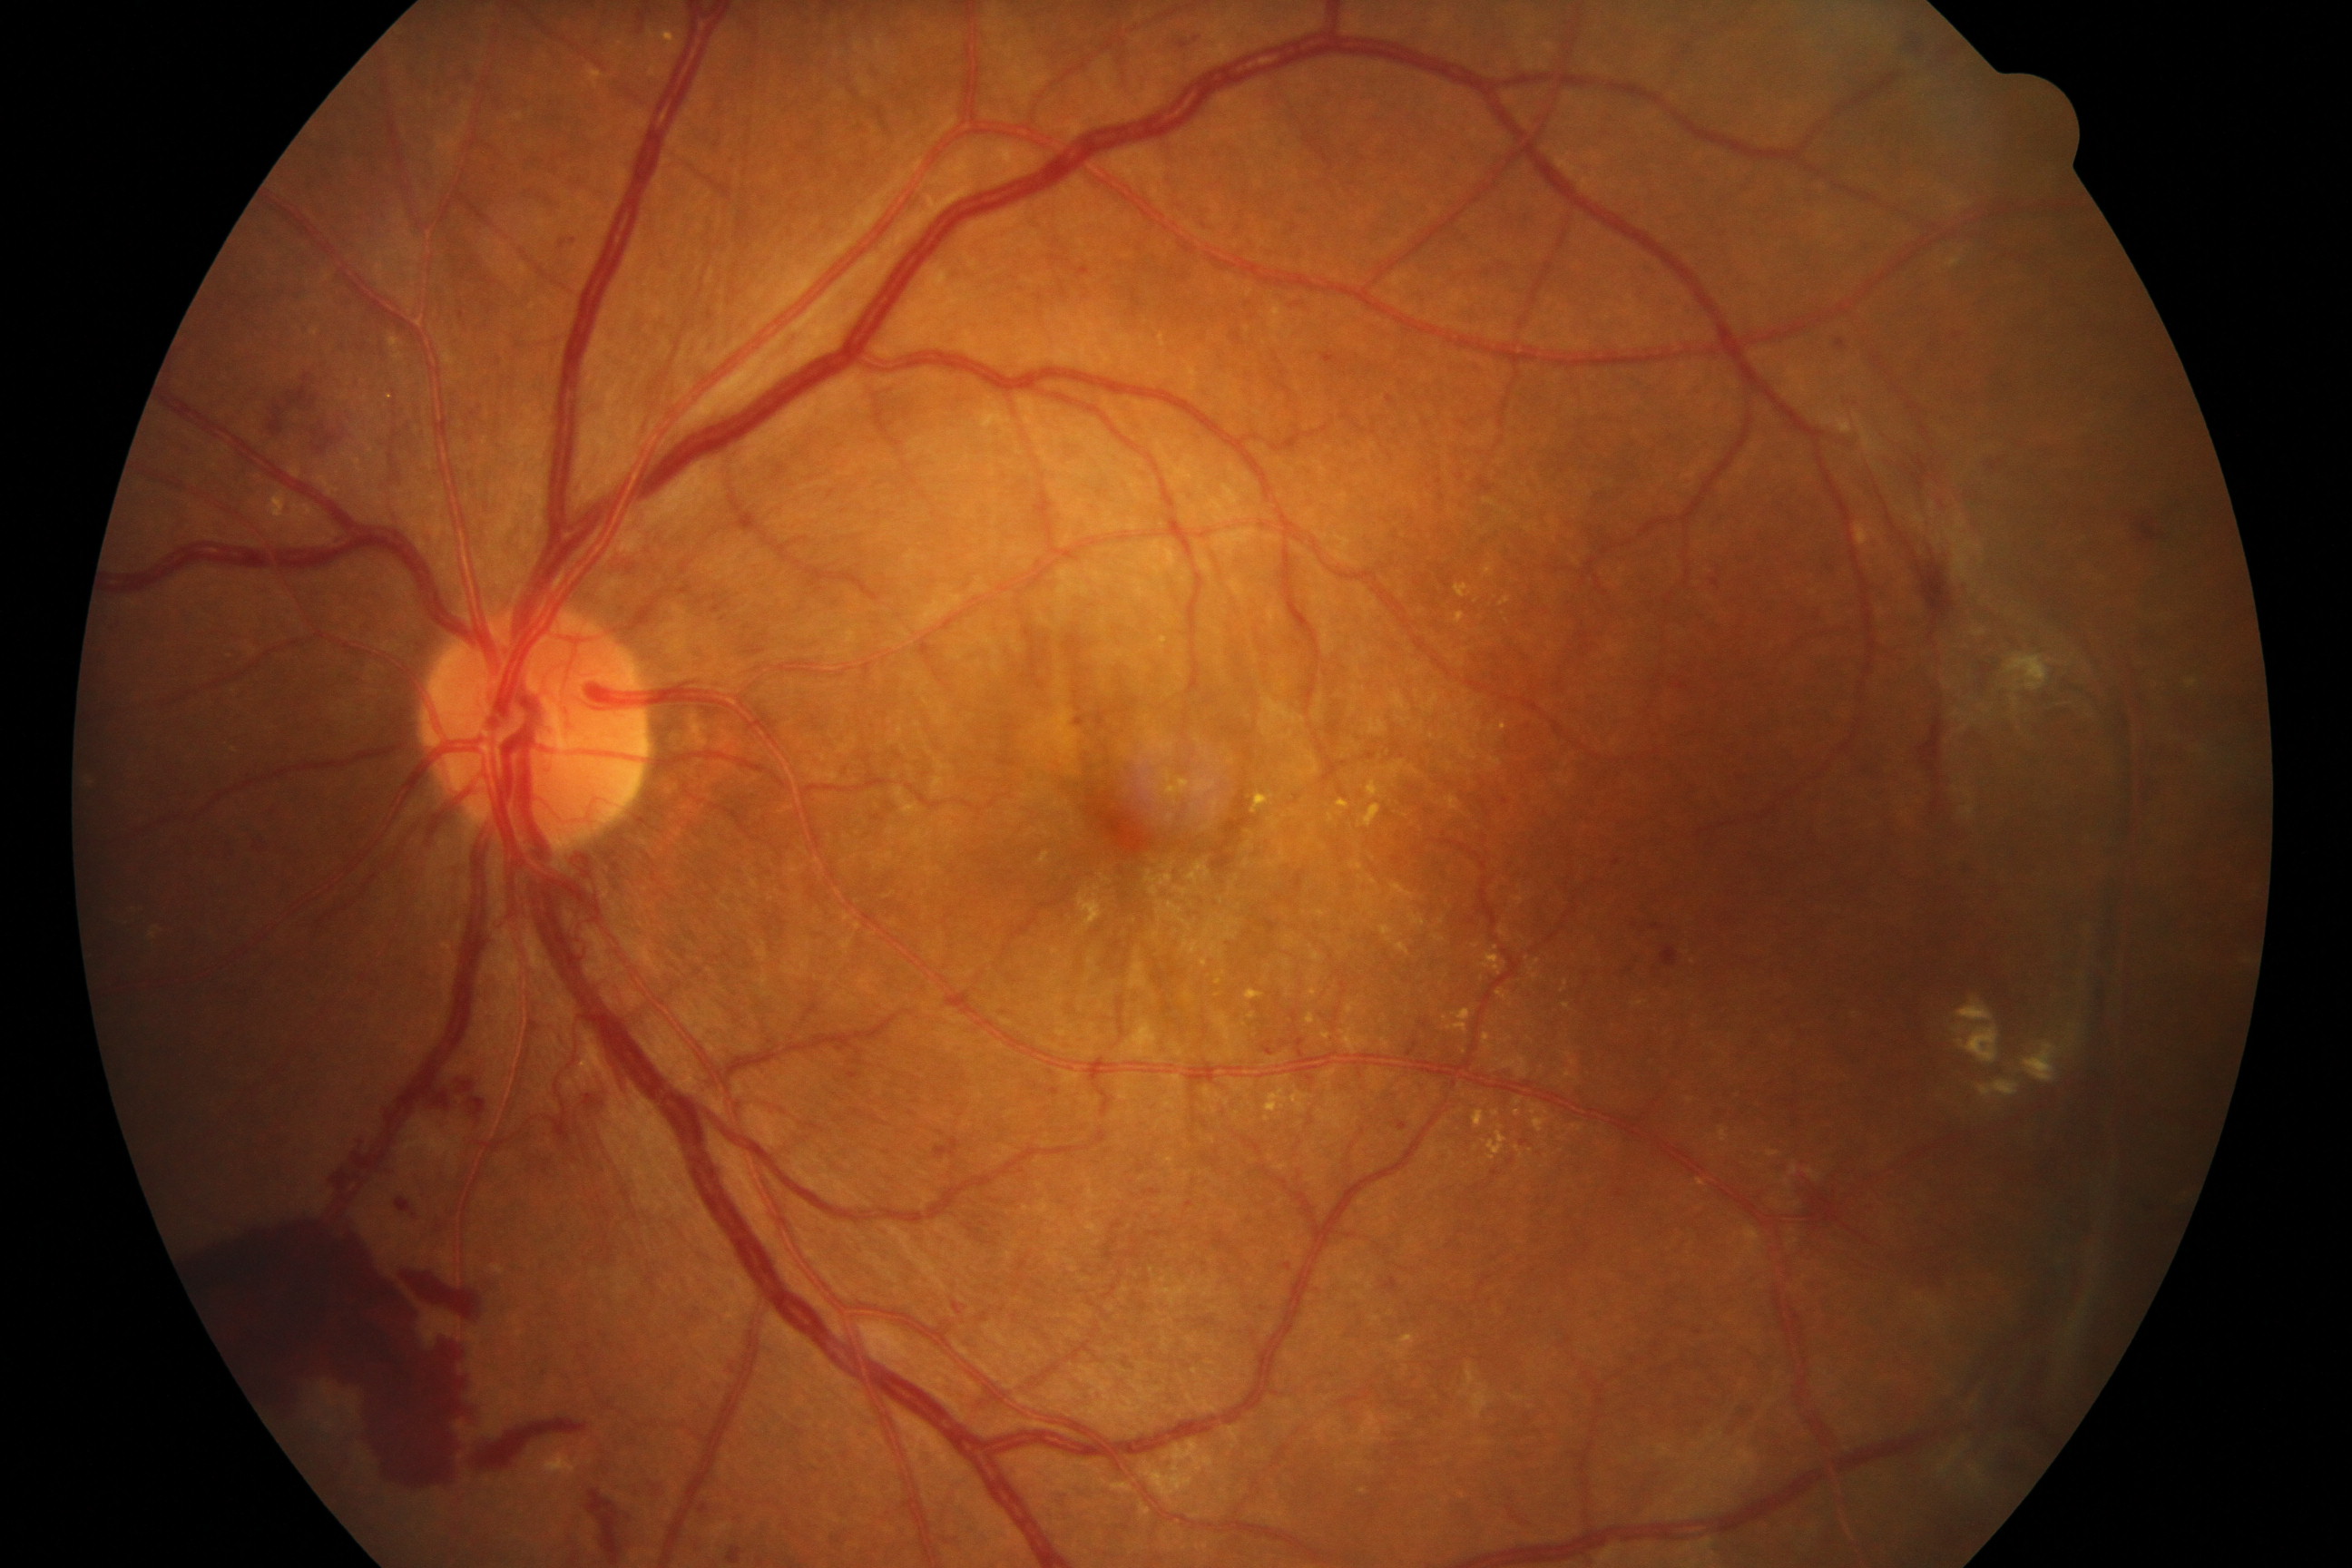 Diagnosis: severe non-proliferative or proliferative diabetic retinopathy.